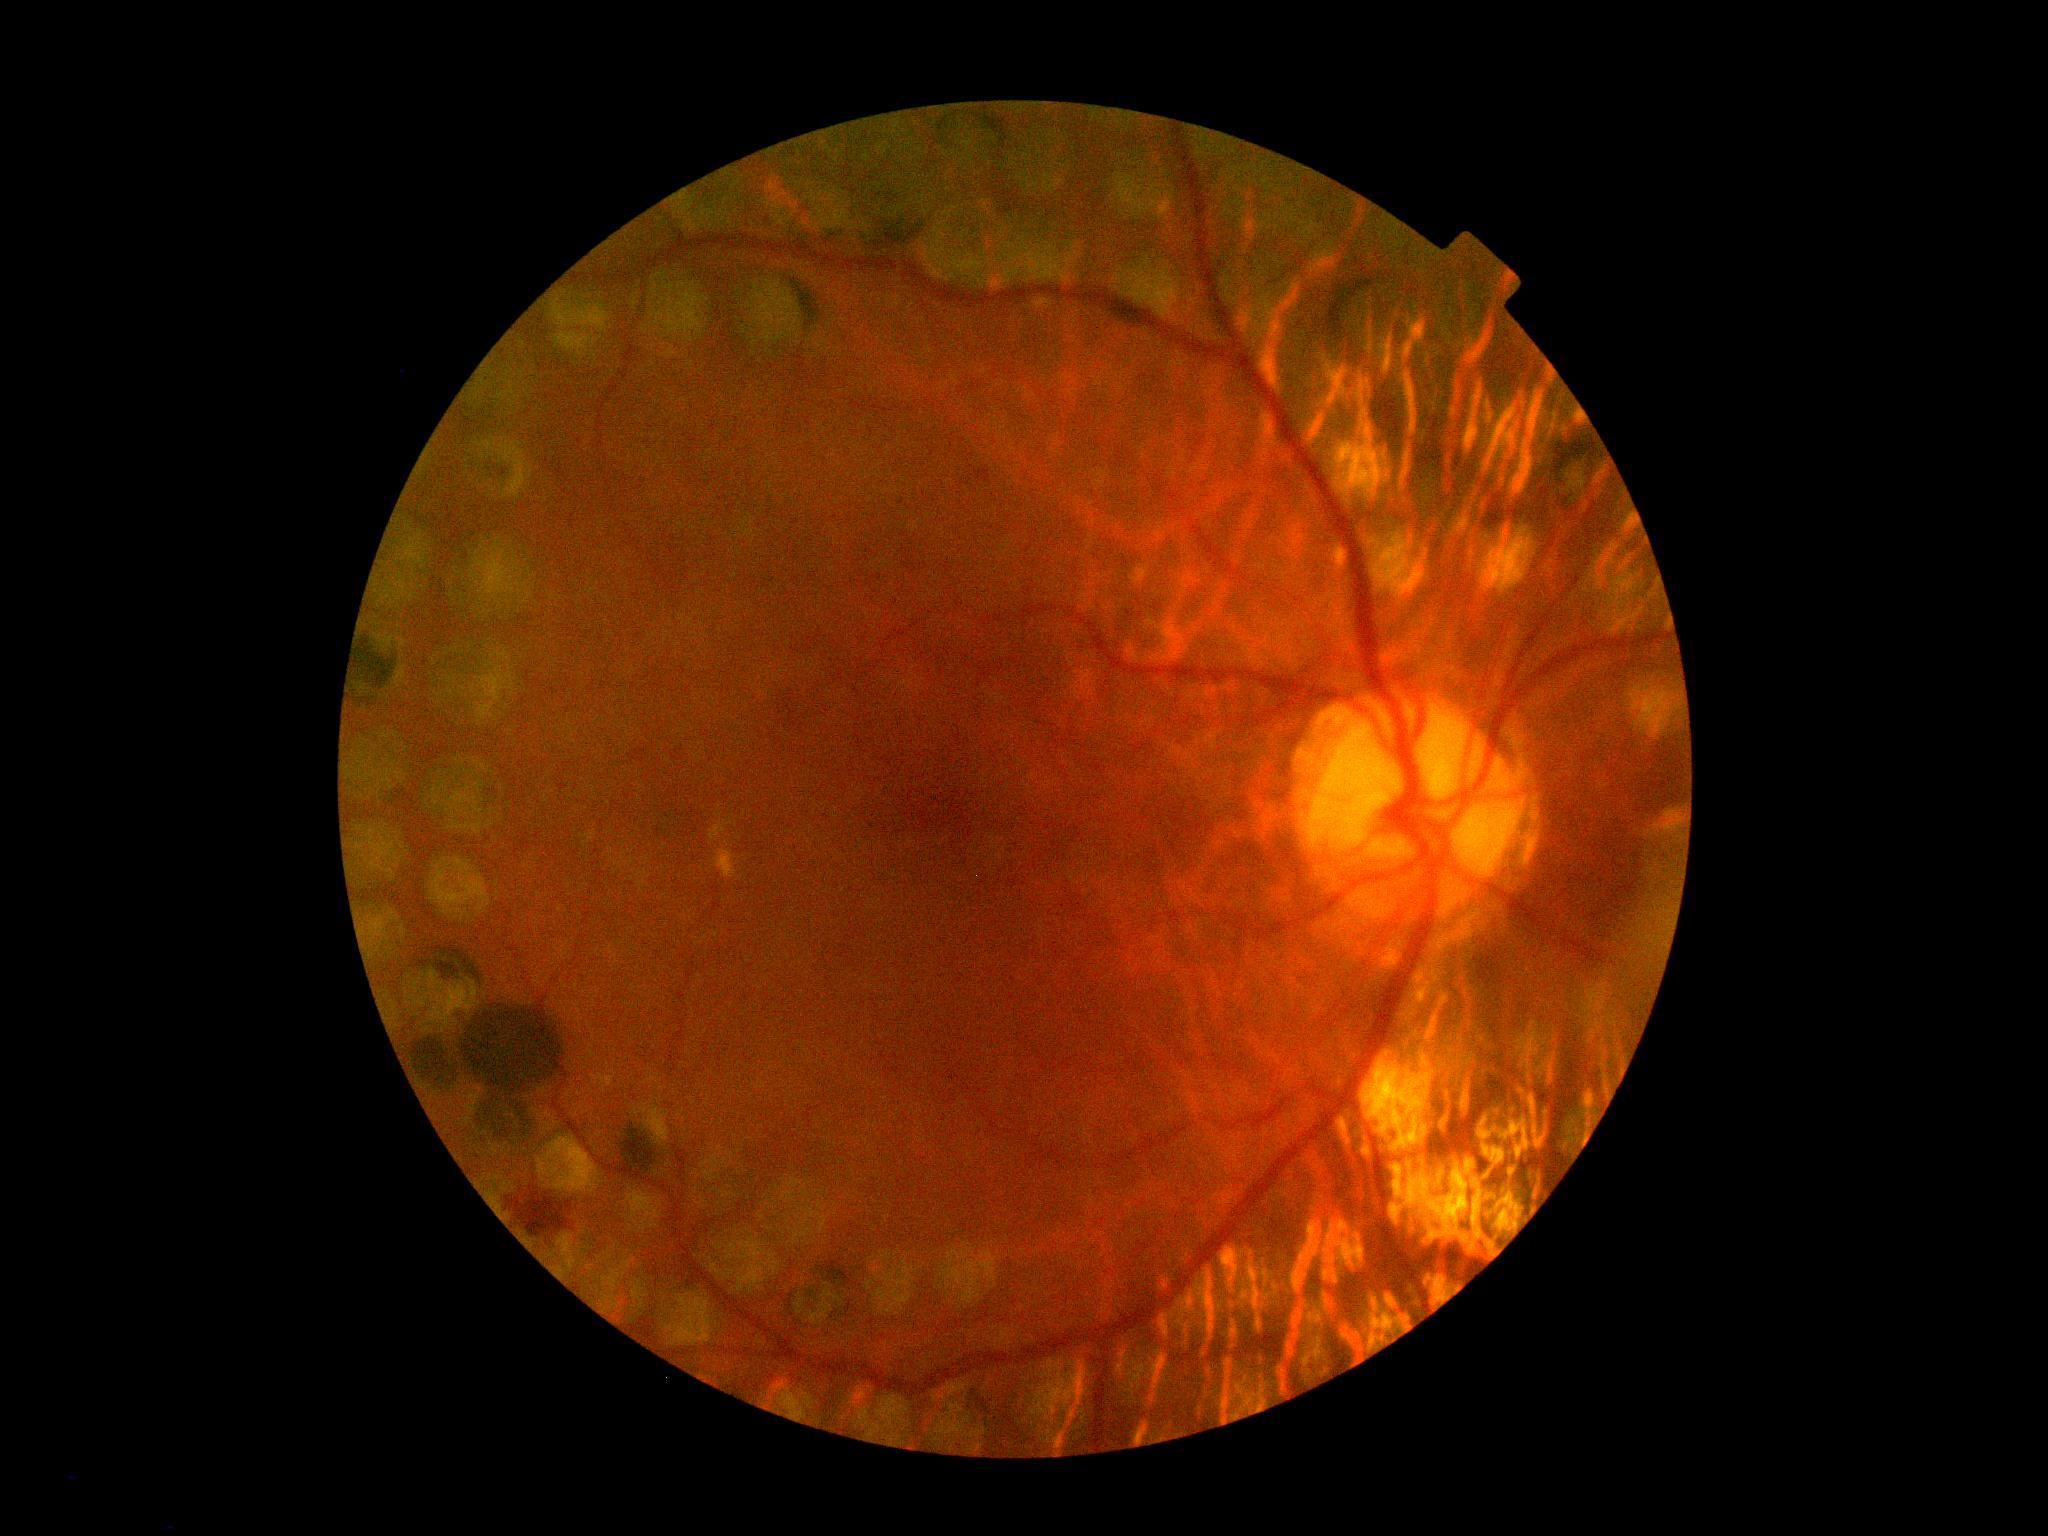

• DR severity — 2/4